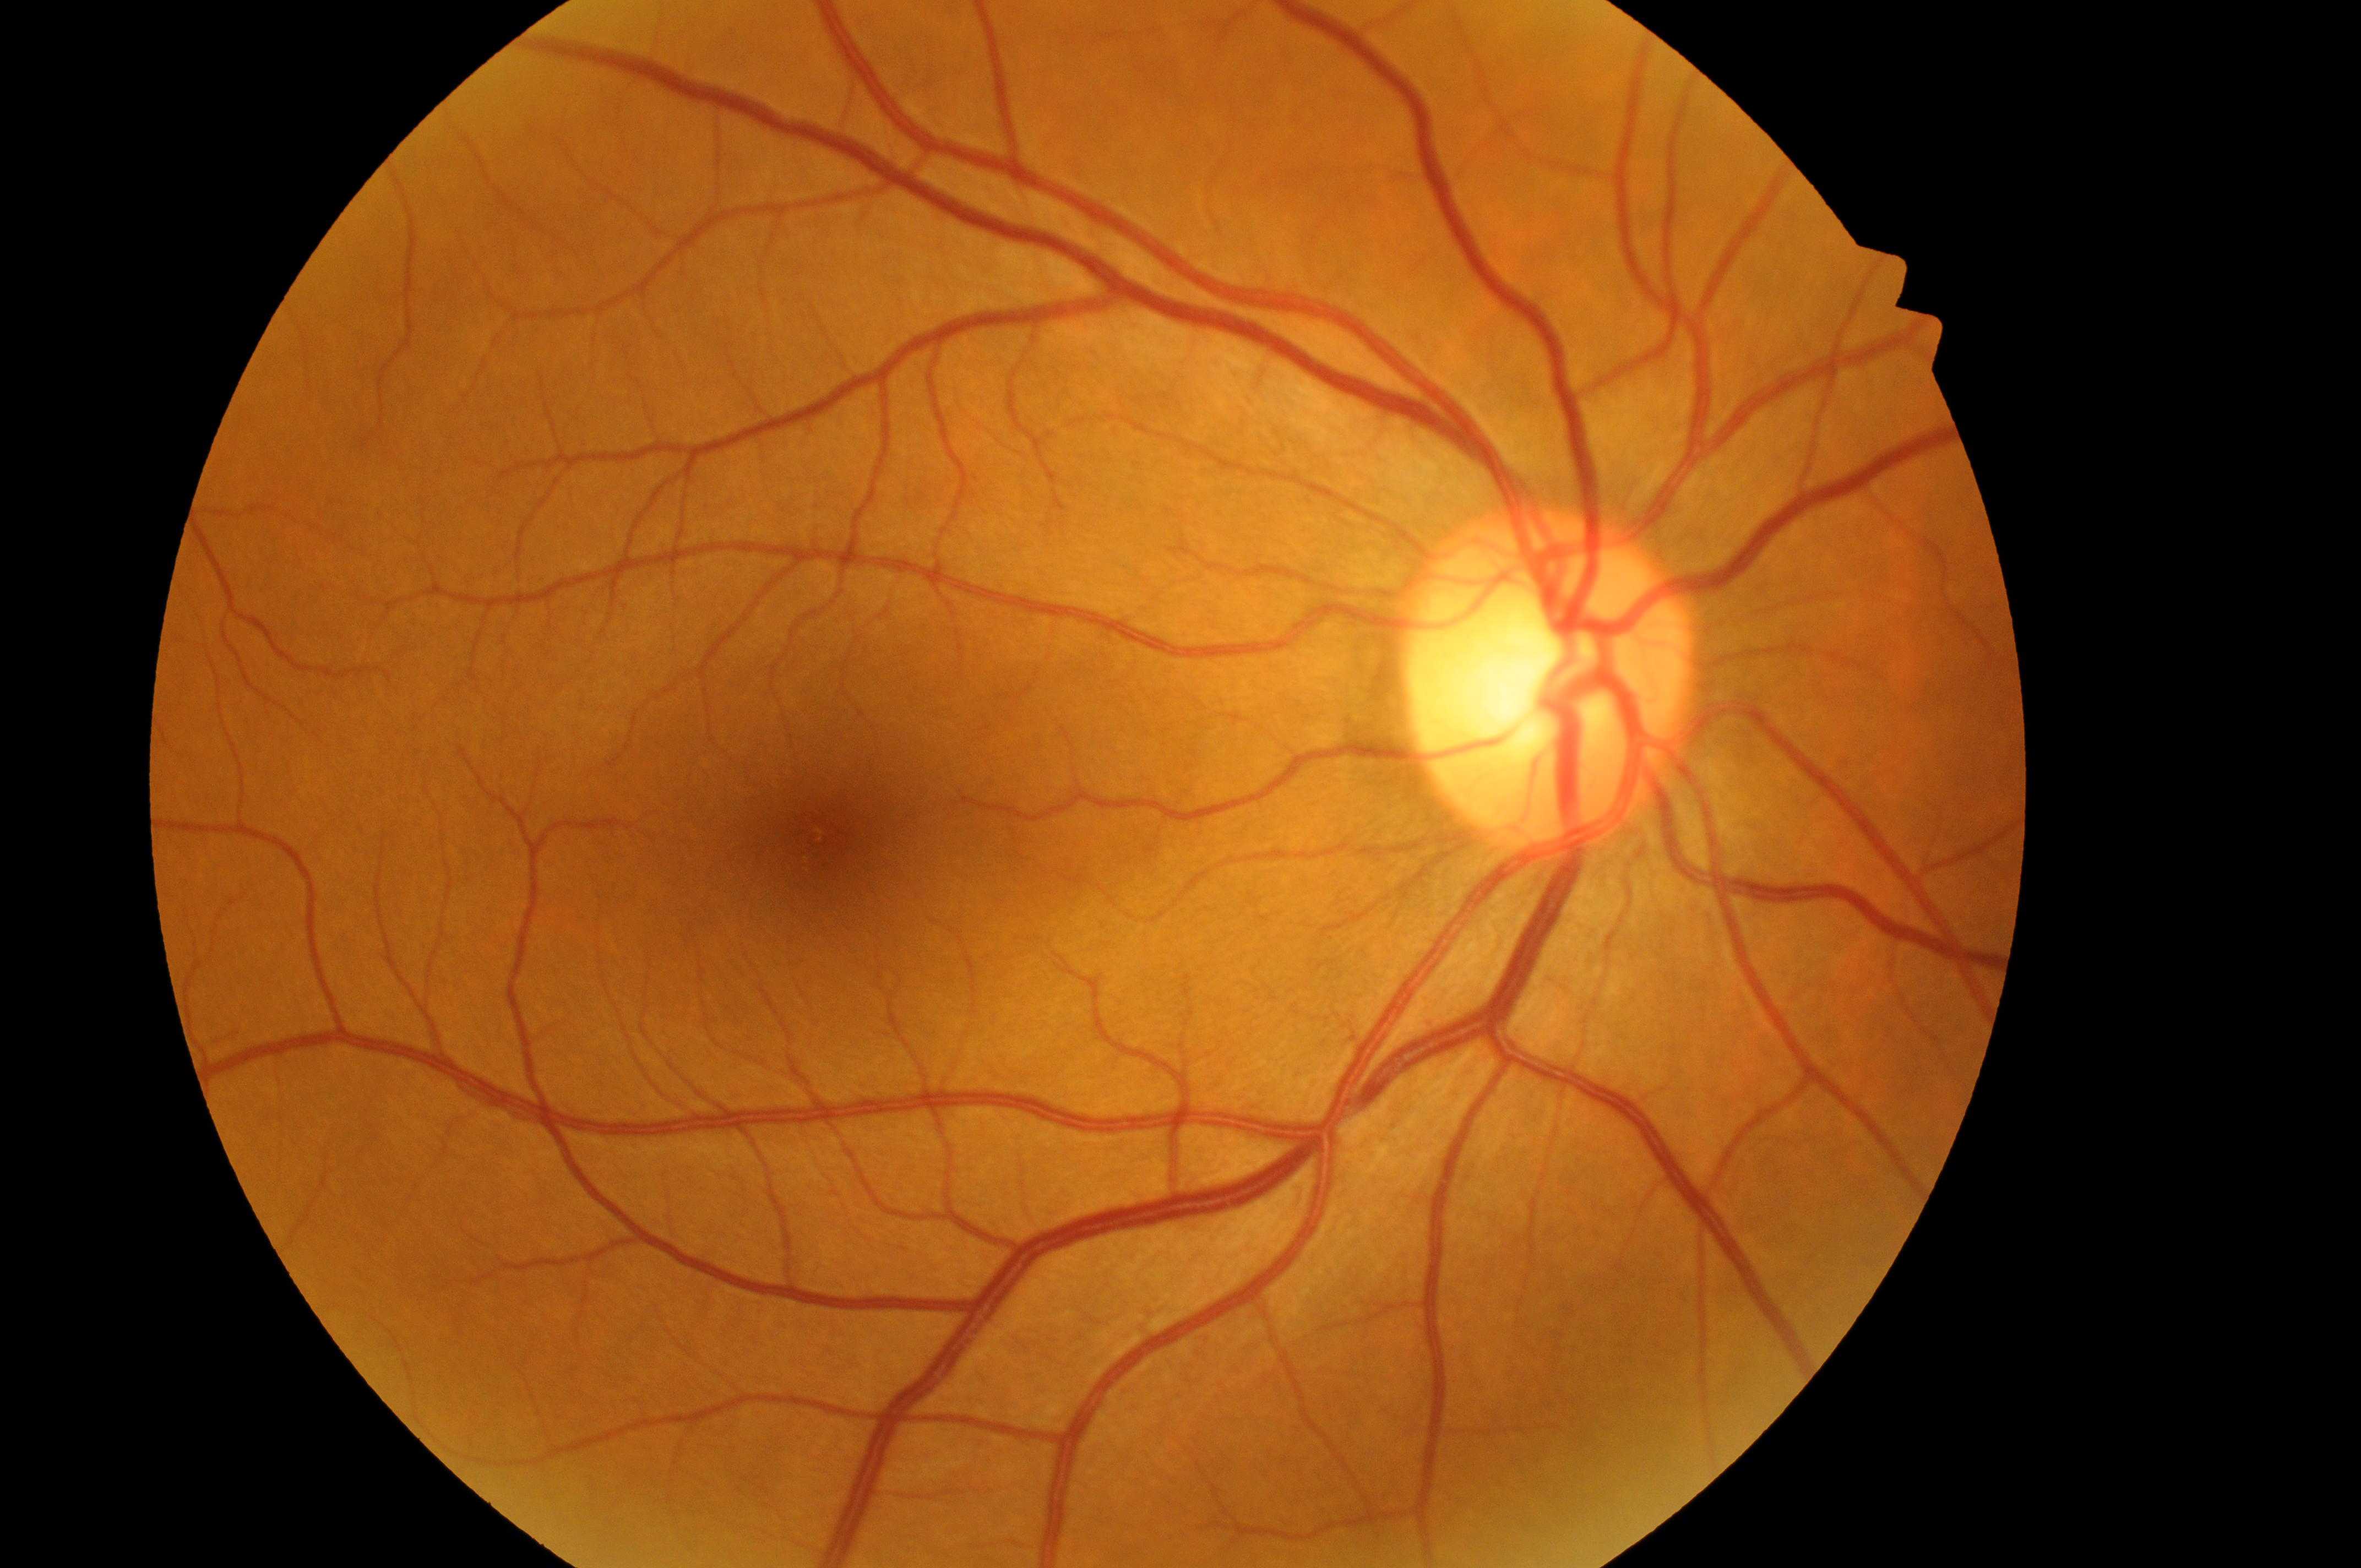 DME = no risk (grade 0) — no apparent hard exudates | fovea = 835px, 835px | DR grade = 0 (no apparent retinopathy) — no visible signs of diabetic retinopathy | laterality = the right eye | disc center = 1543px, 693px.